Nonmydriatic fundus photograph; graded on the modified Davis scale: 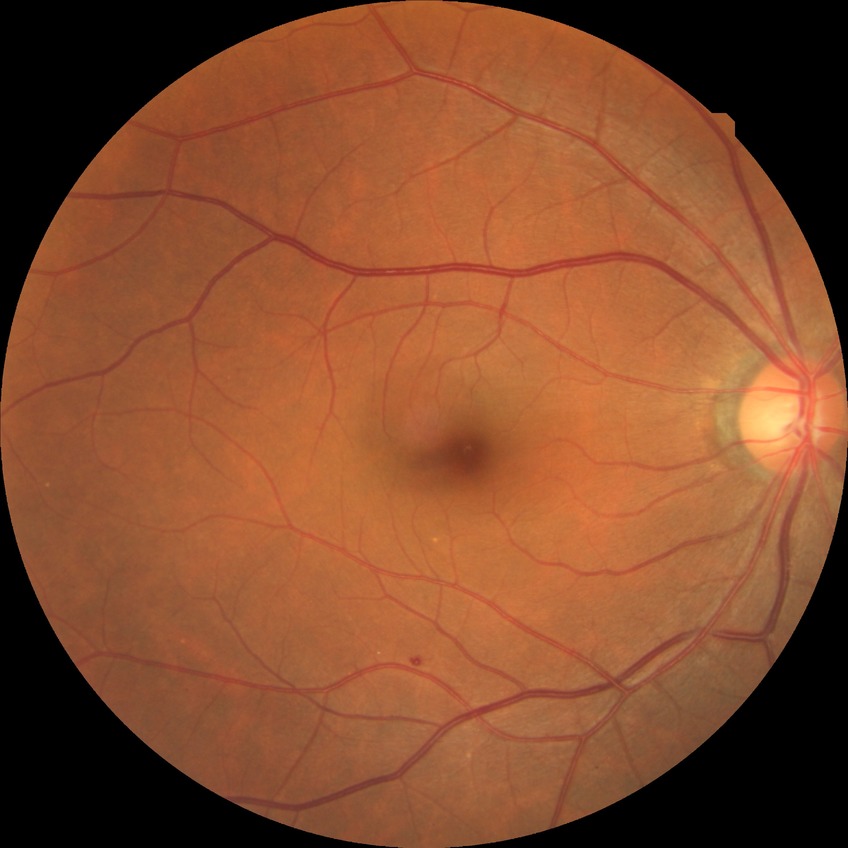 Diabetic retinopathy (DR): NDR (no diabetic retinopathy).